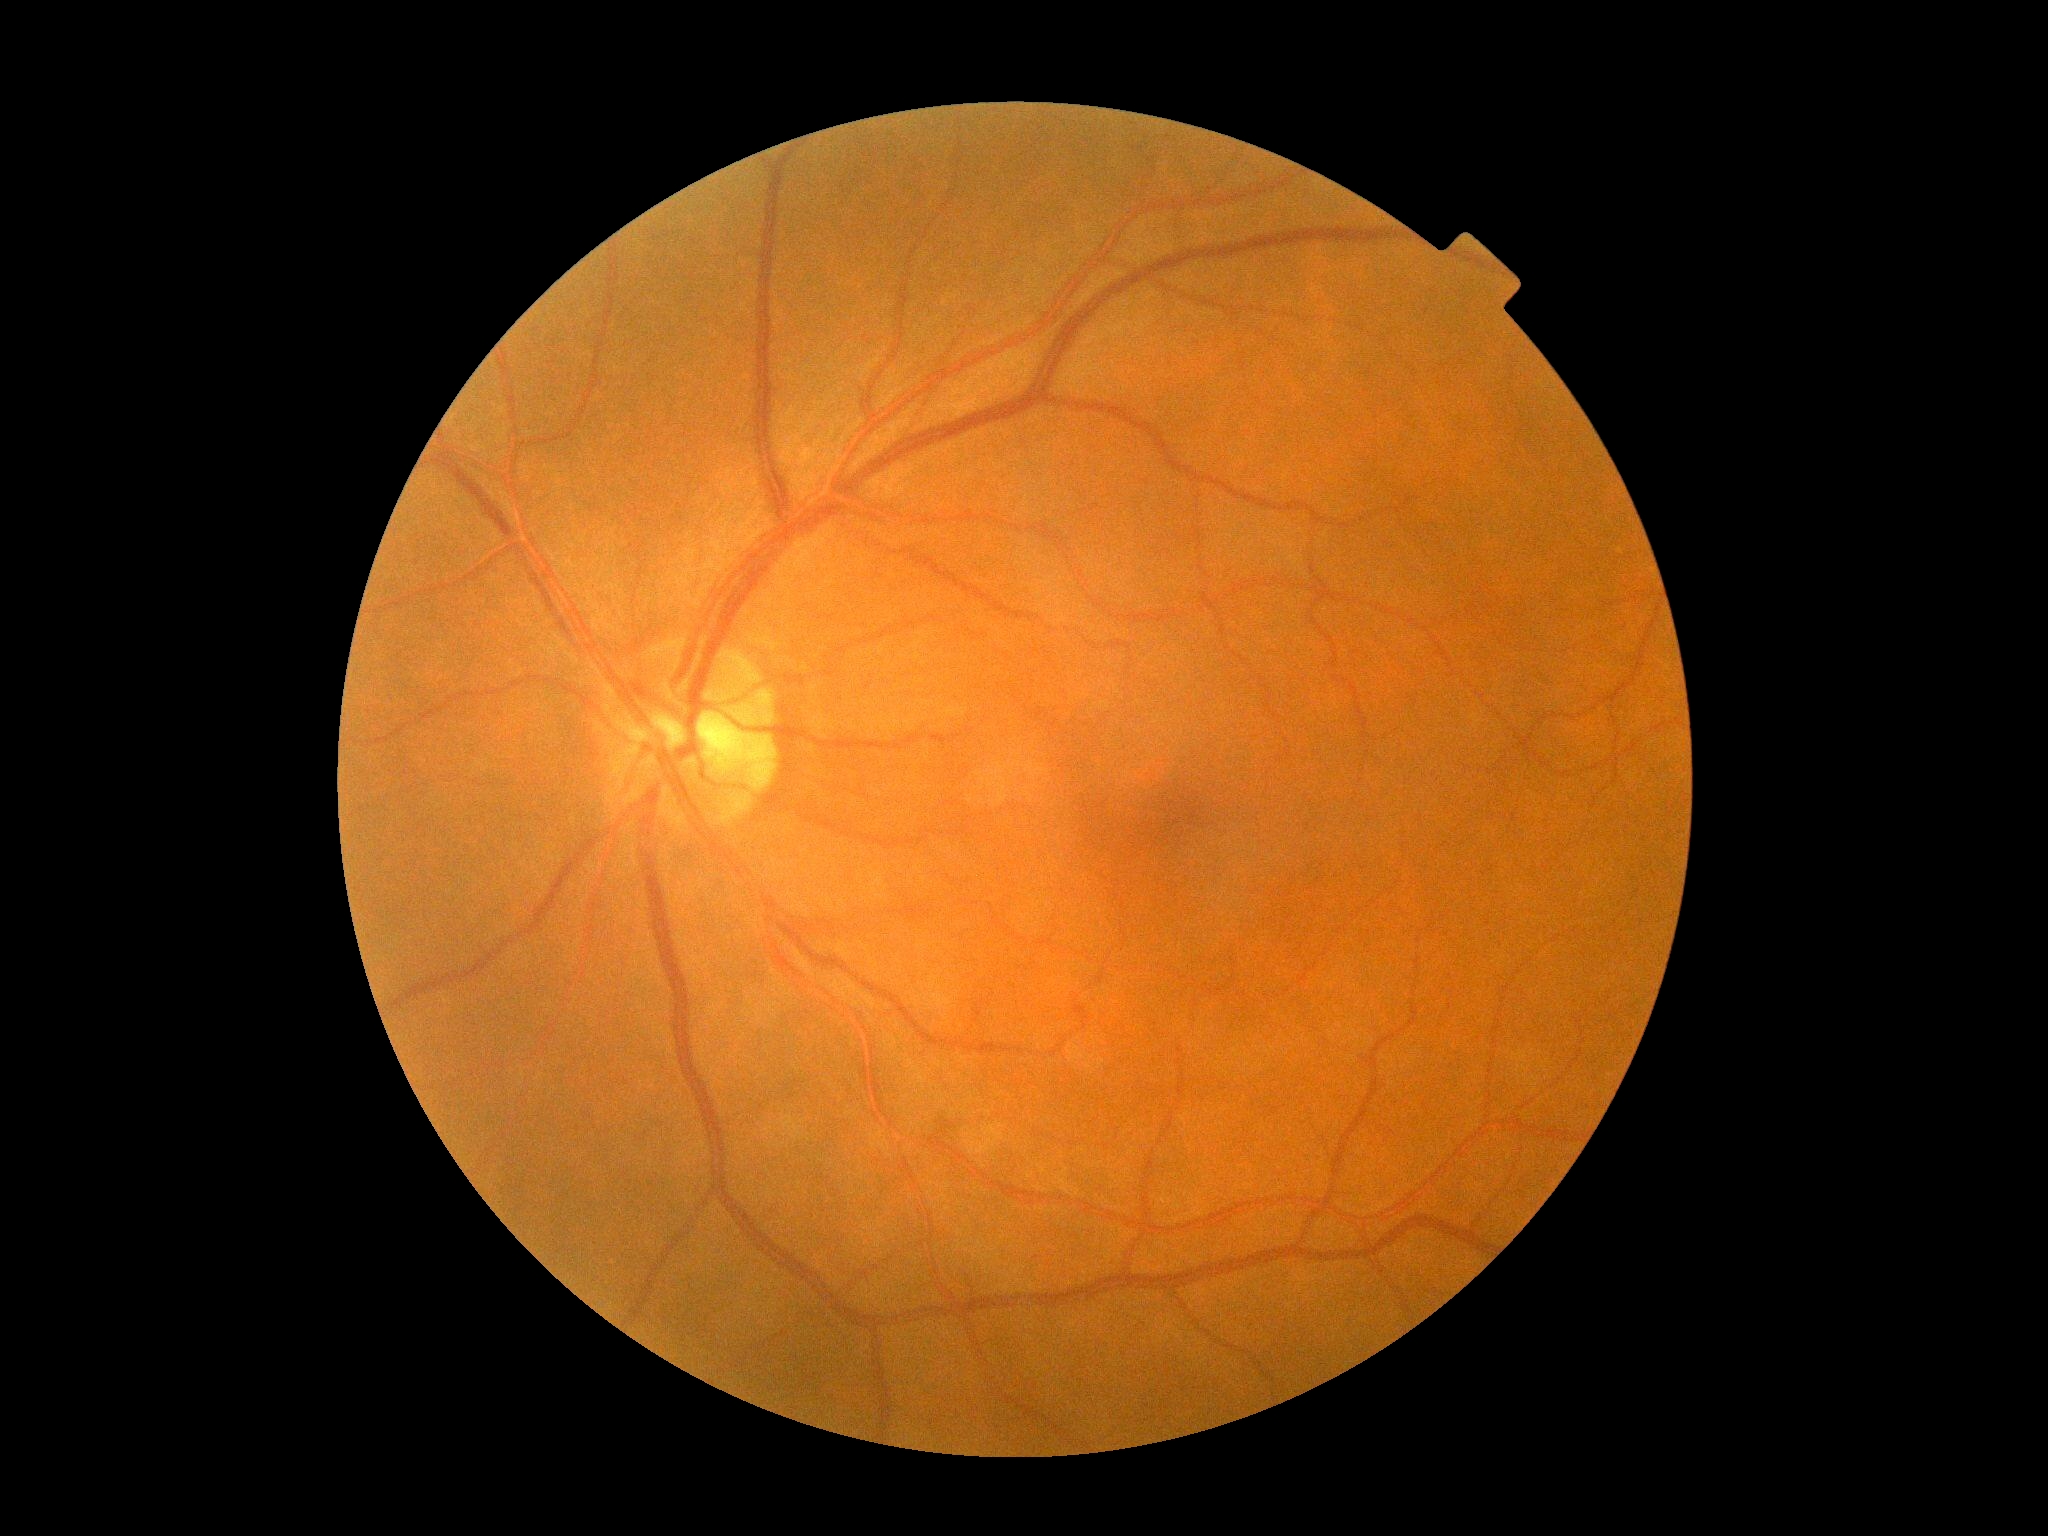

Retinopathy grade is 0.